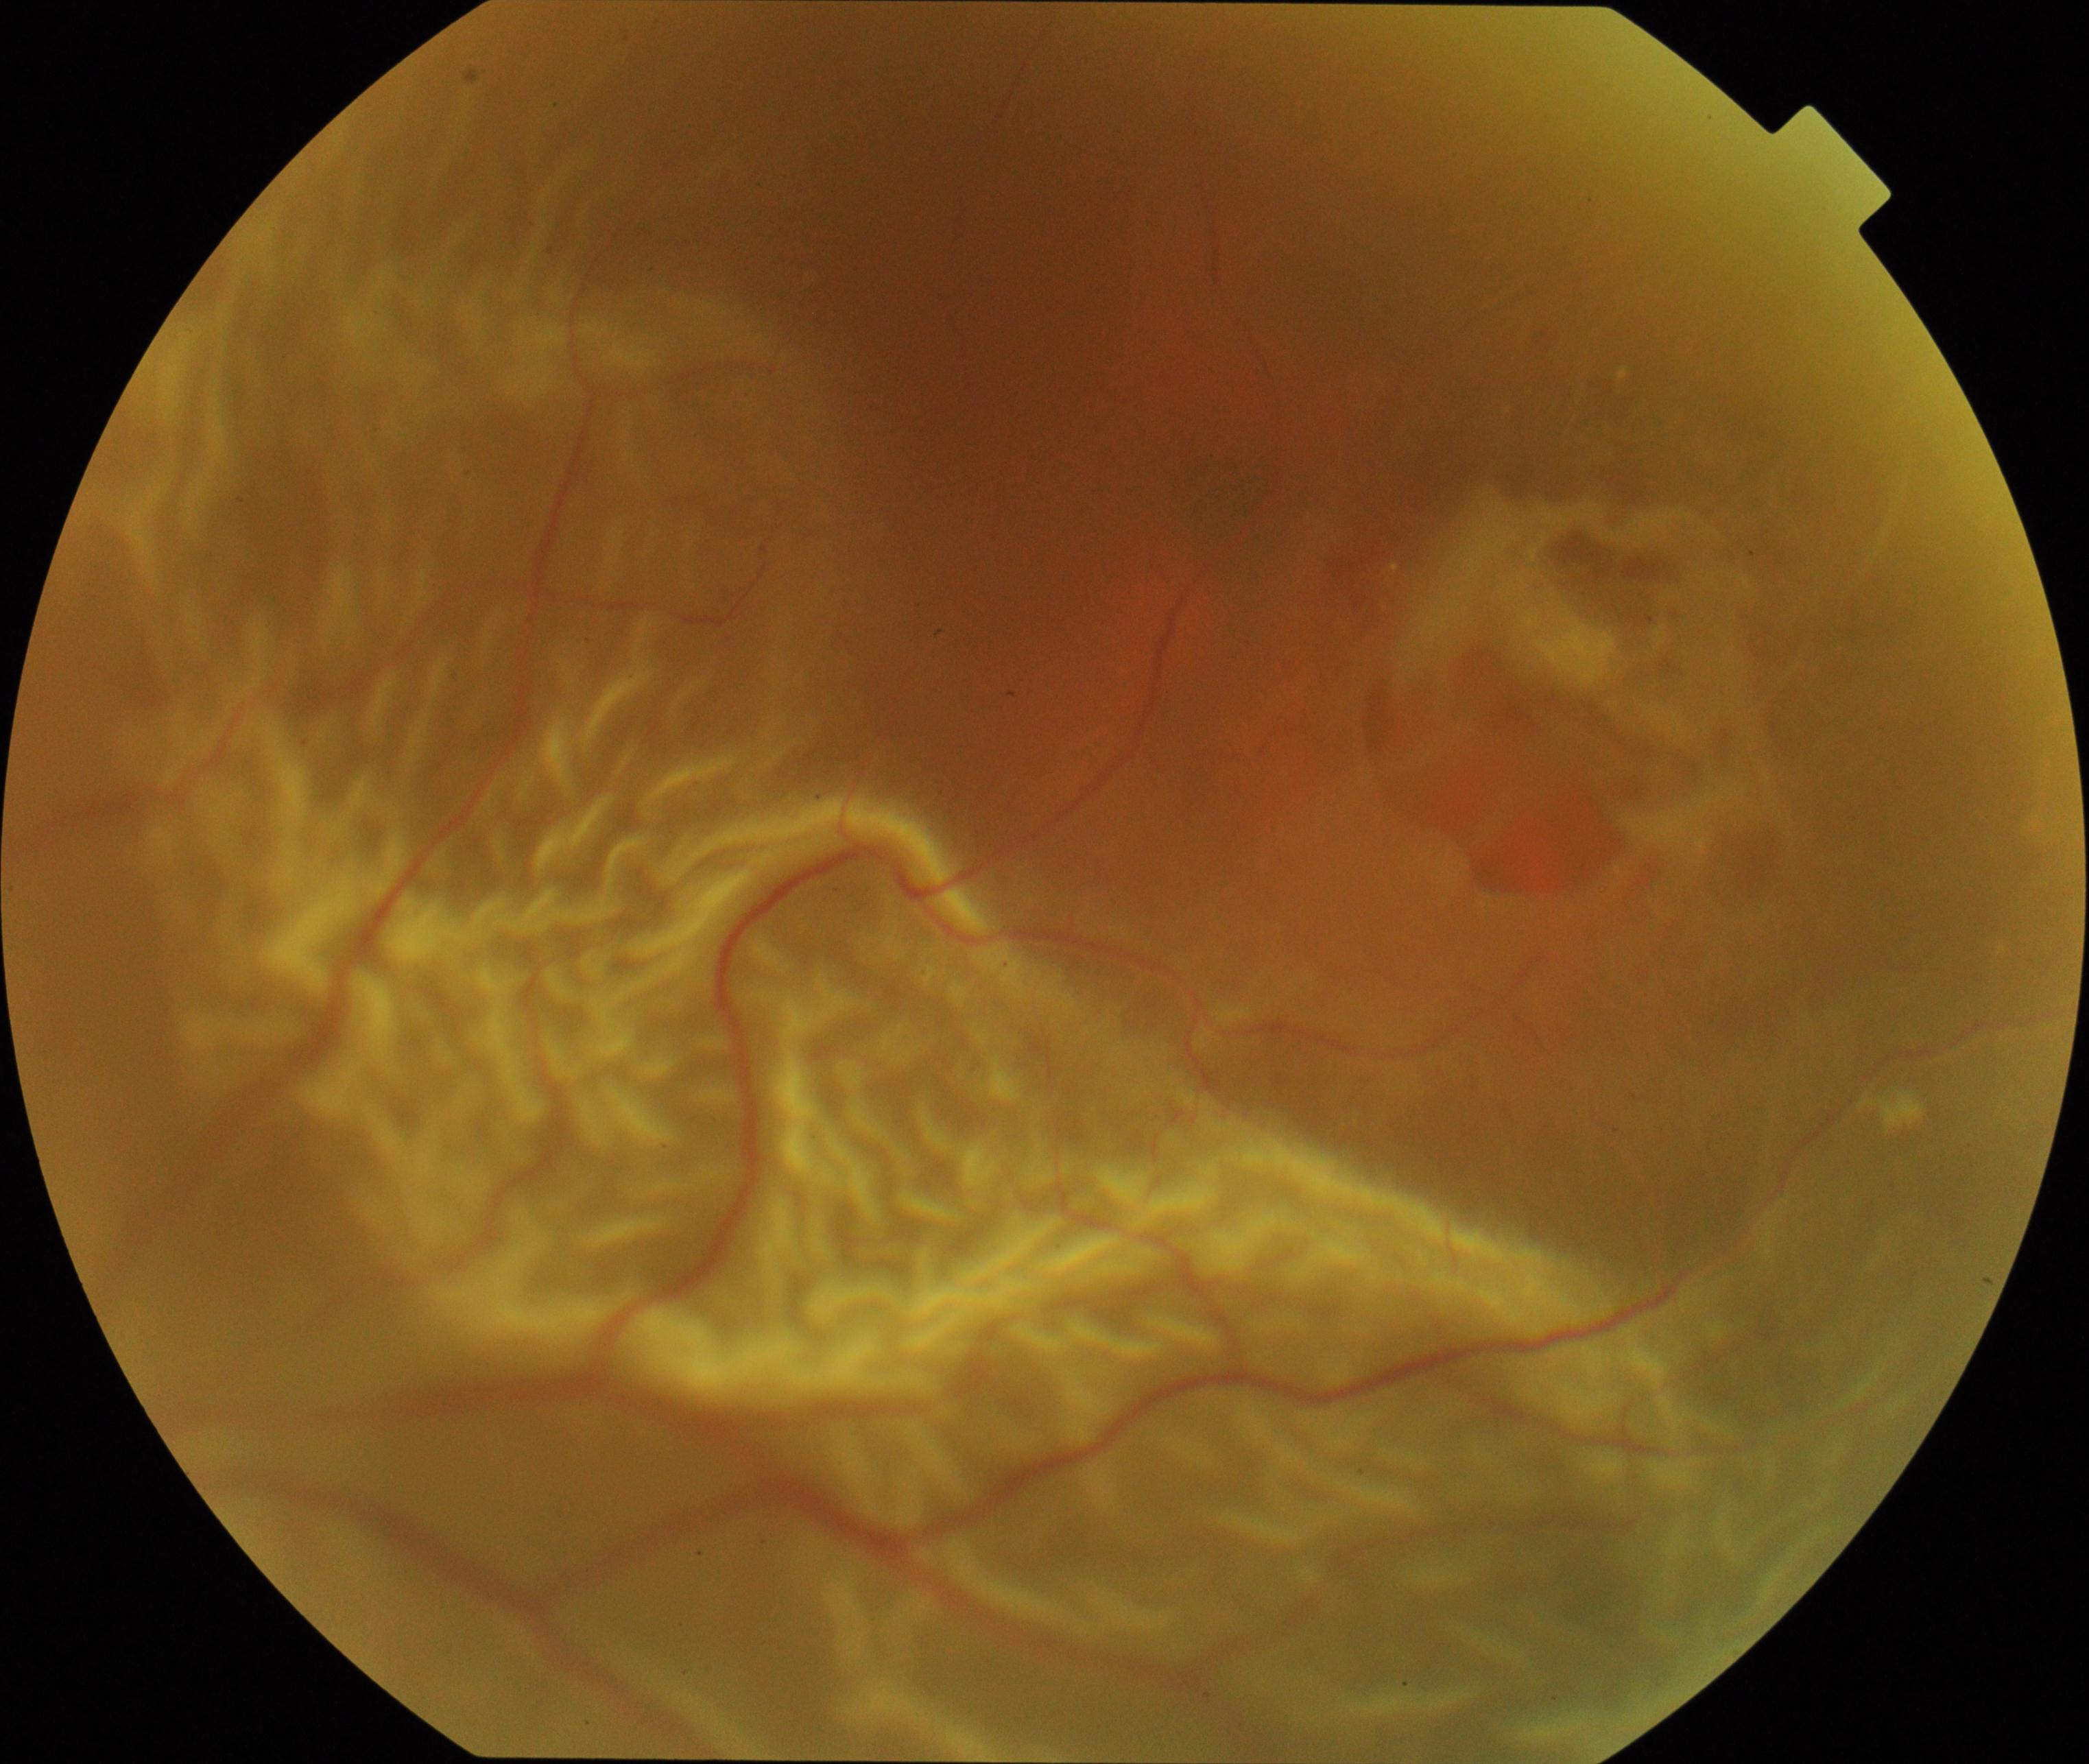 Diagnosis: rhegmatogenous retinal detachment.